45° field of view. 2048x1536px. Retinal fundus photograph
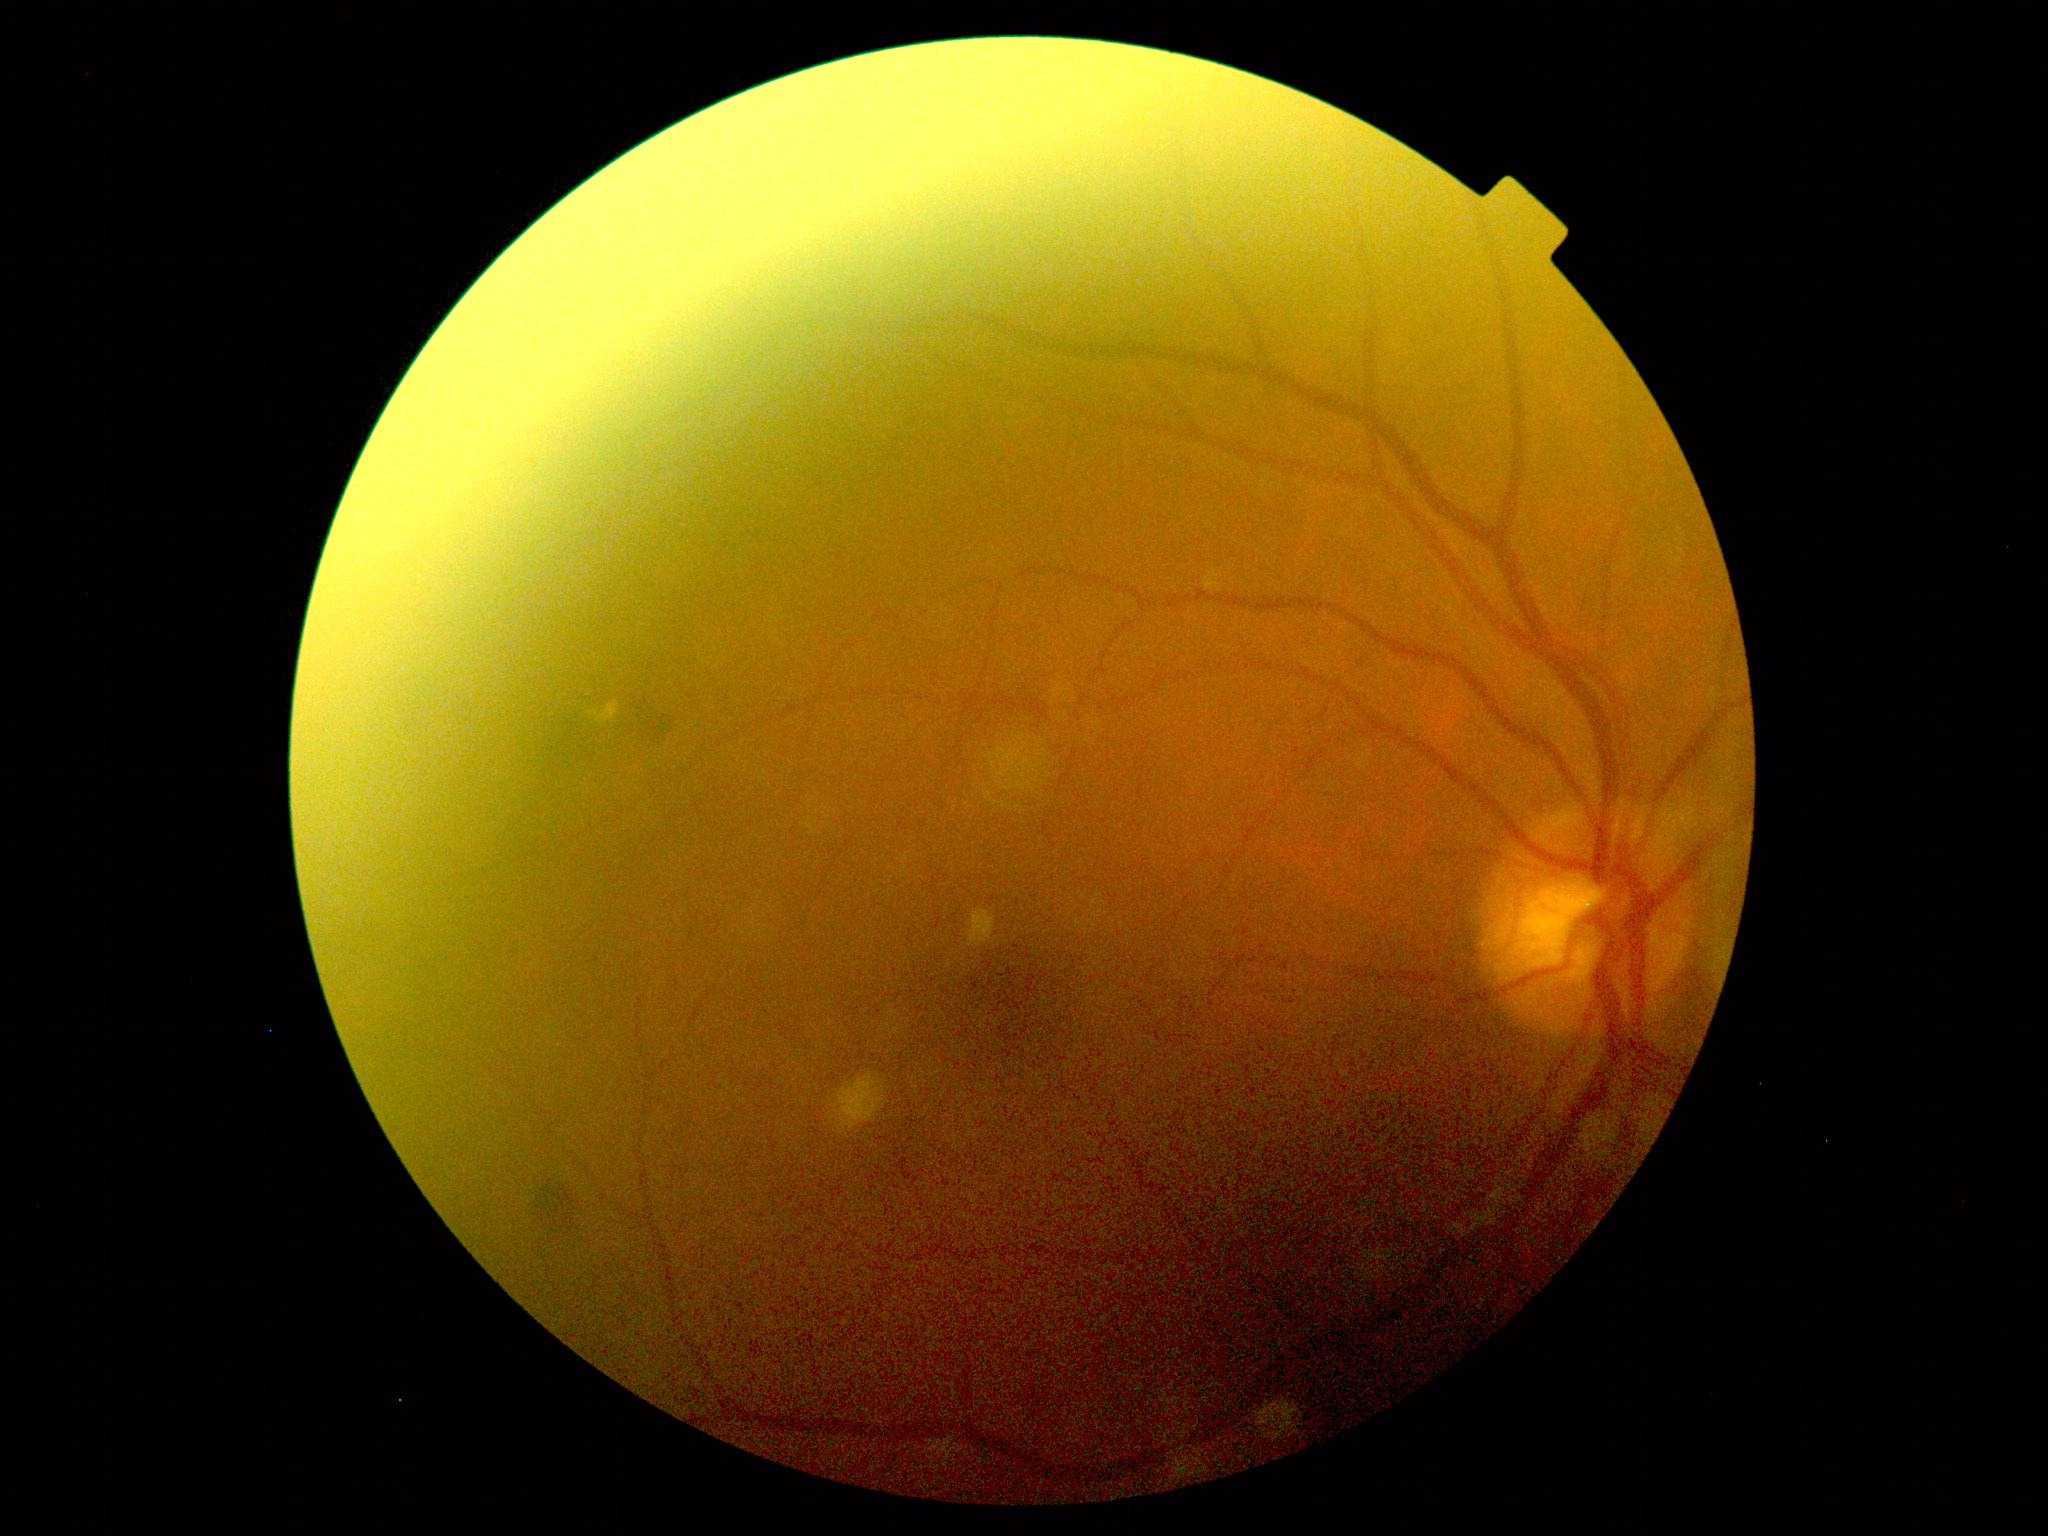 – DR stage — grade 2 (moderate NPDR)